CFP. Camera: NIDEK AFC-230 — 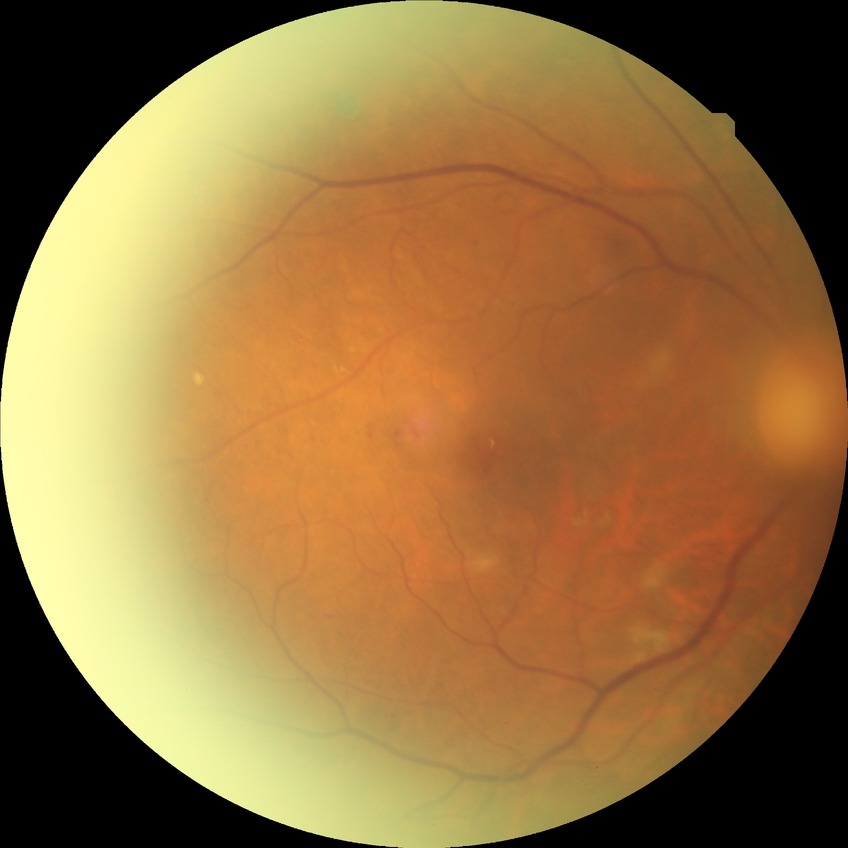

Diabetic retinopathy (DR): proliferative diabetic retinopathy (PDR).